848x848, color fundus photograph, NIDEK AFC-230, FOV: 45 degrees — 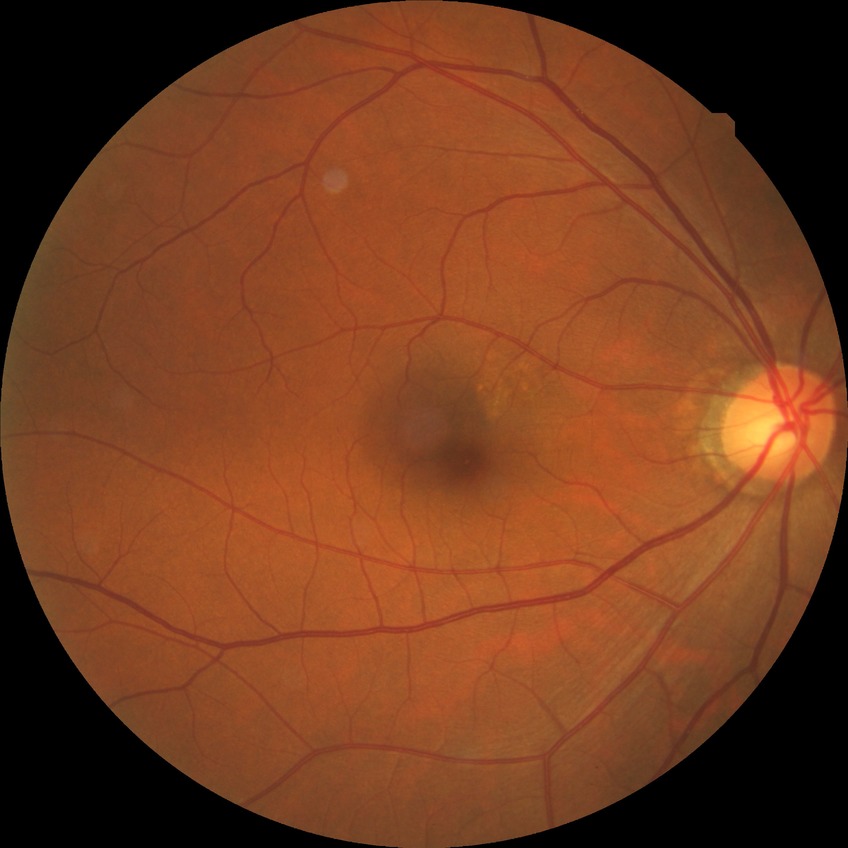

Retinopathy grade is no diabetic retinopathy.